45° FOV: 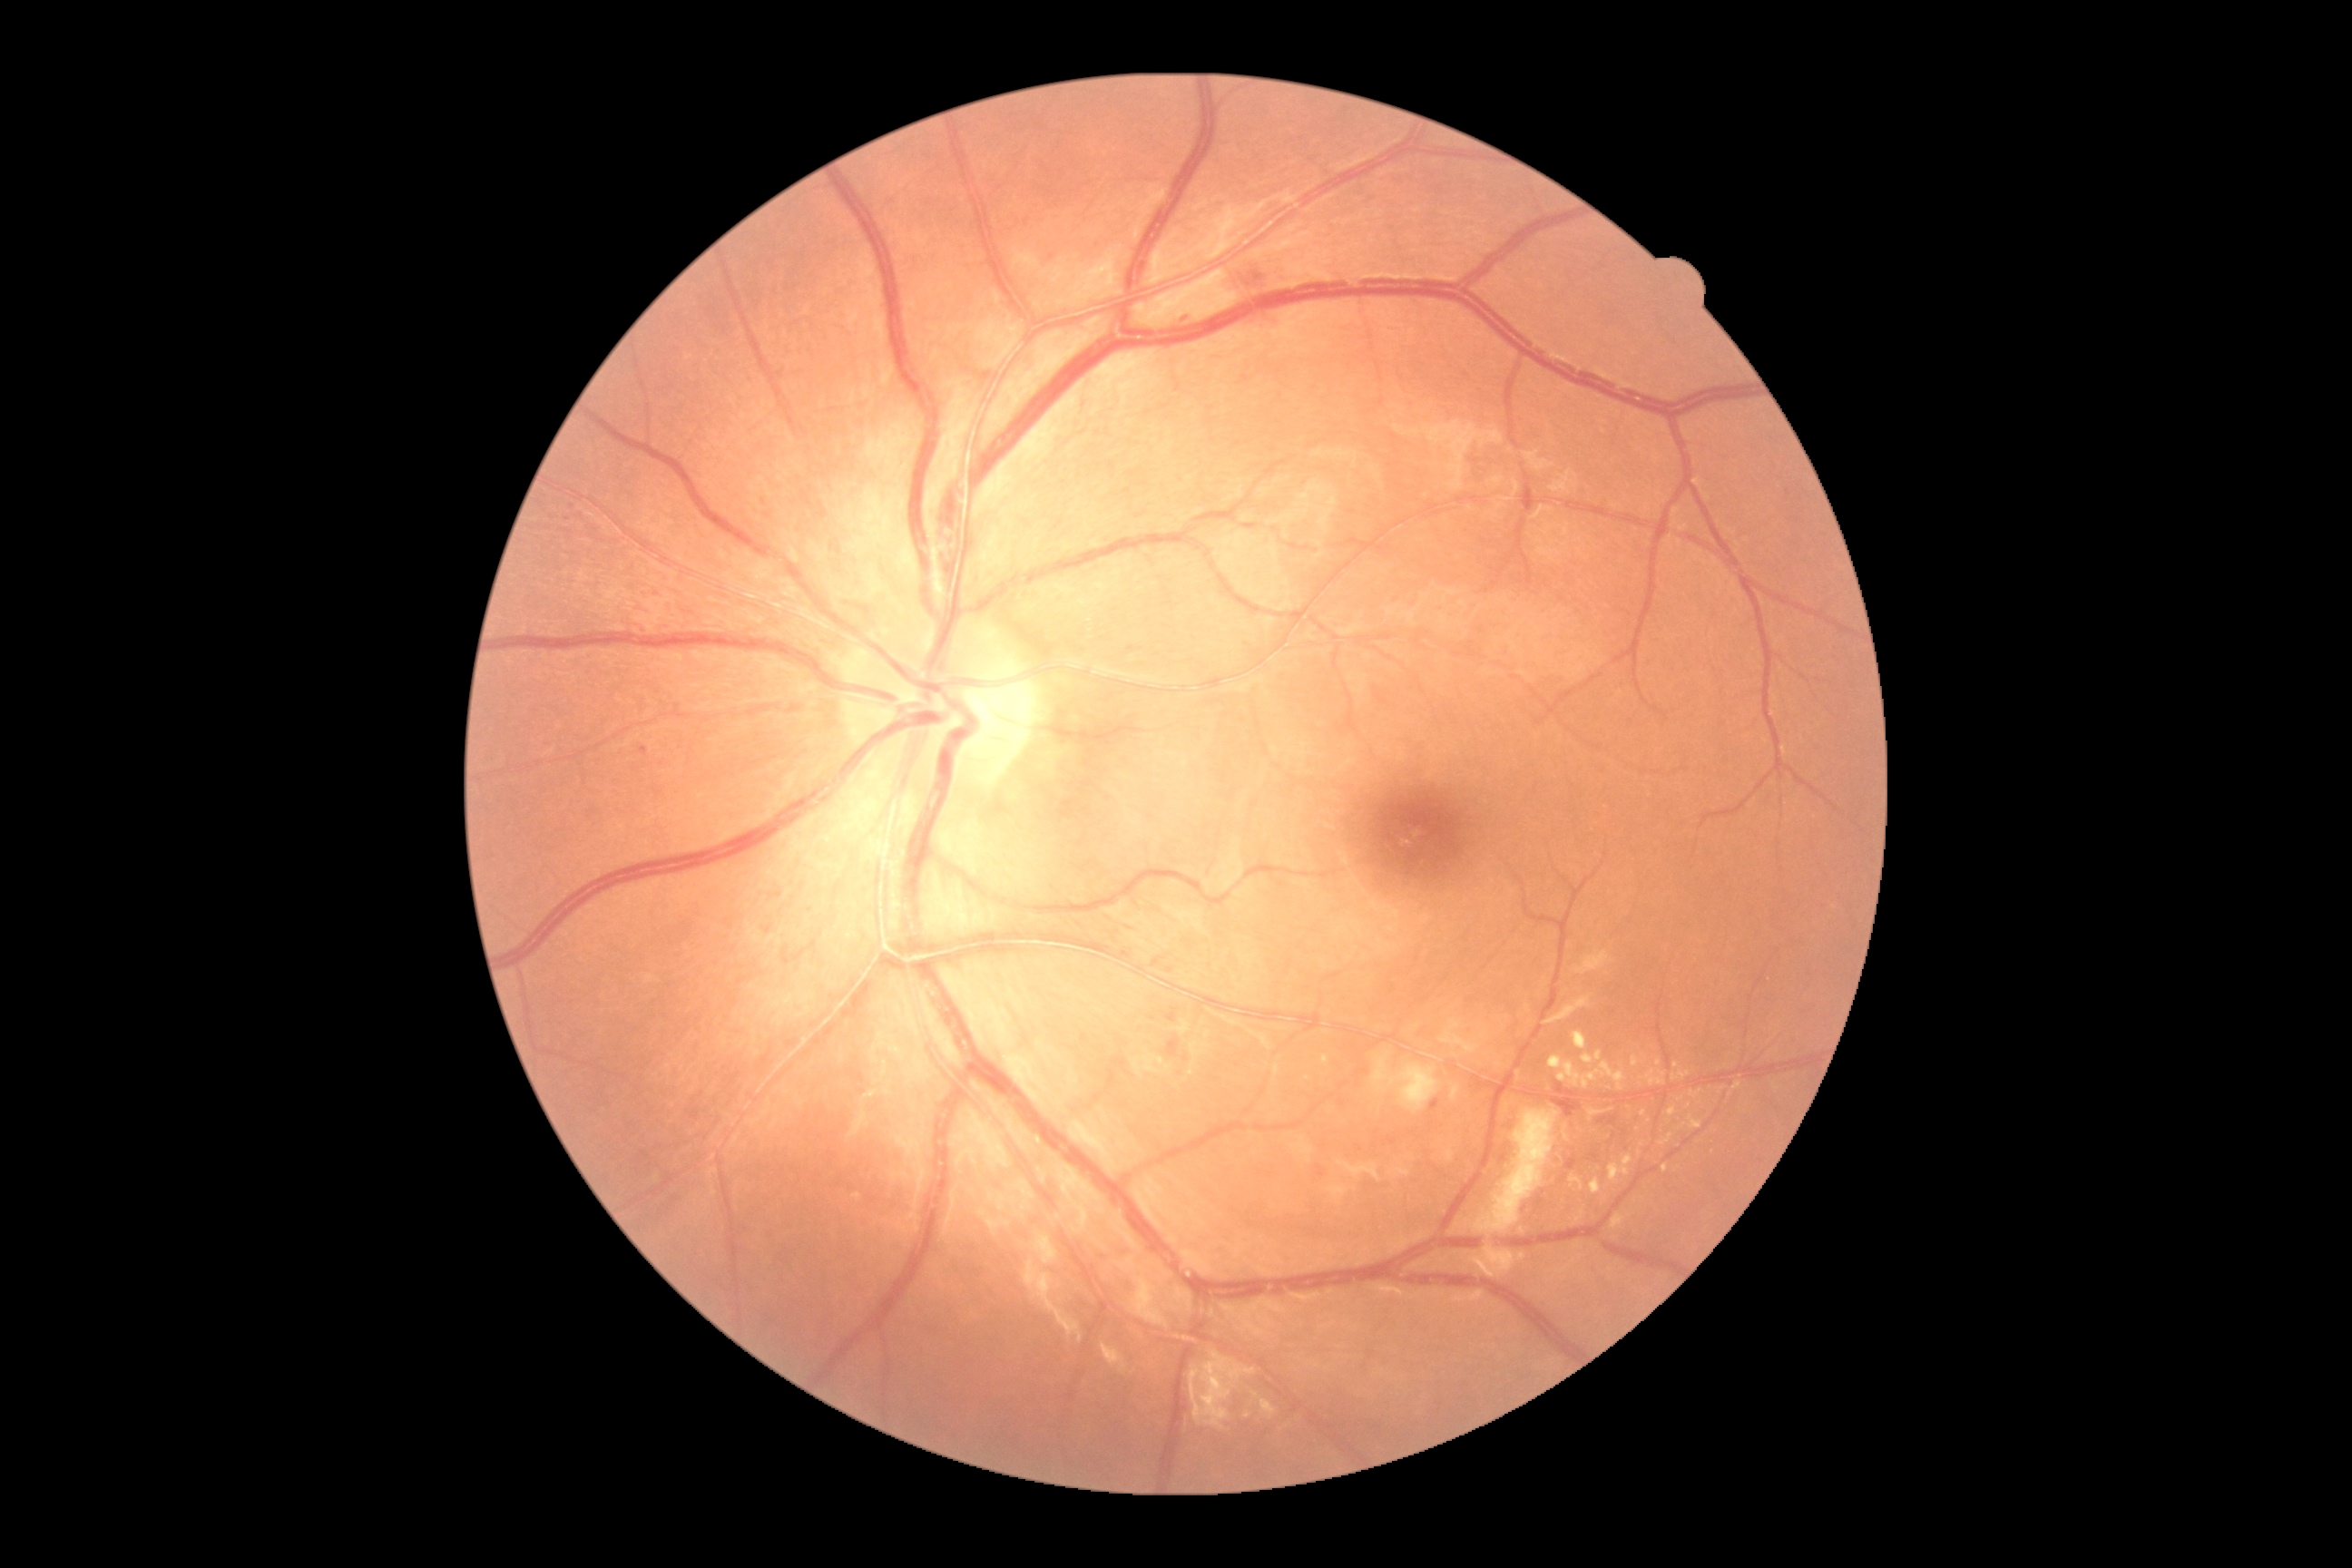

DR severity is 2/4 — more than just microaneurysms but less than severe NPDR.